Retinal fundus photograph: 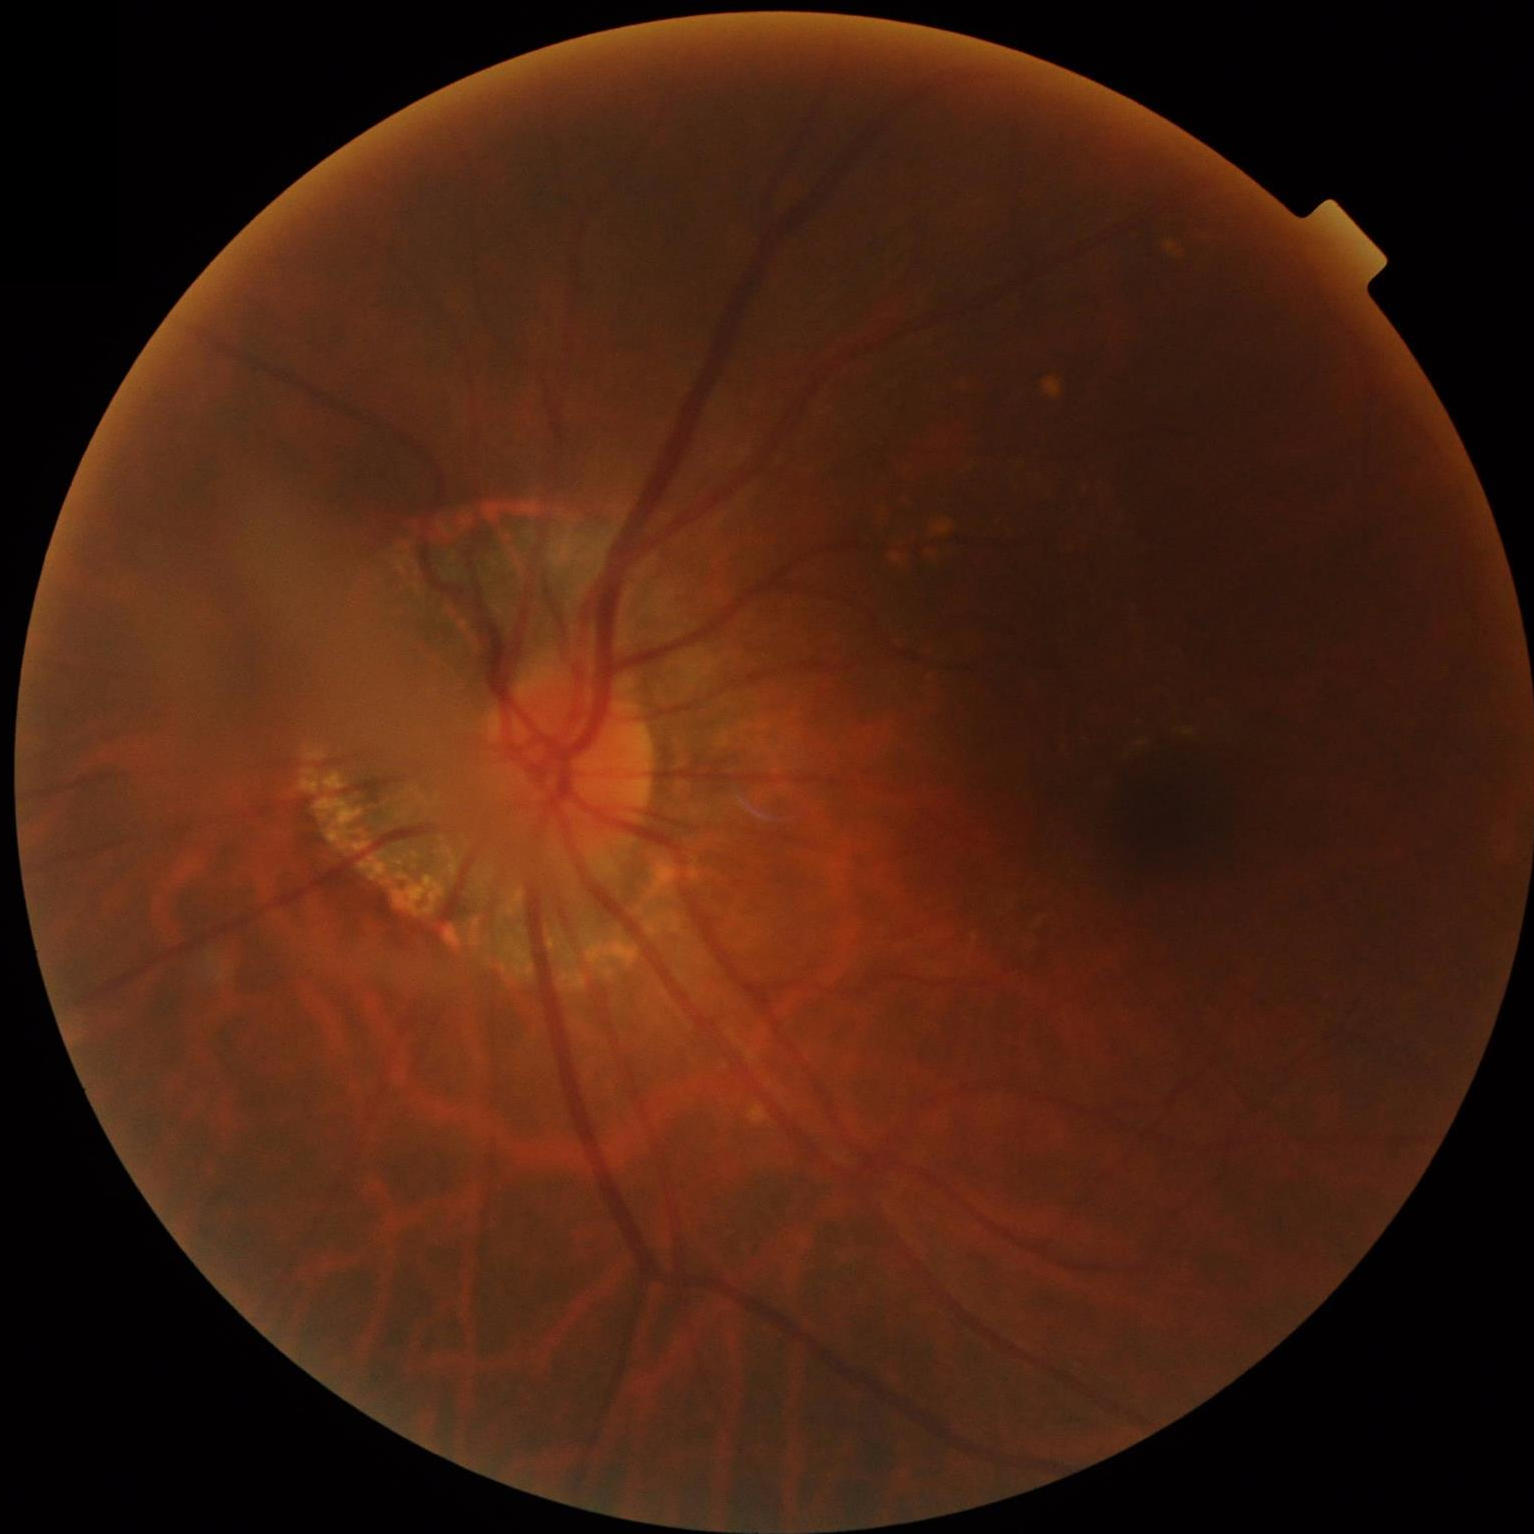
Image quality is suboptimal. No over- or under-exposure. Reduced sharpness with visible blur.